45° FOV.
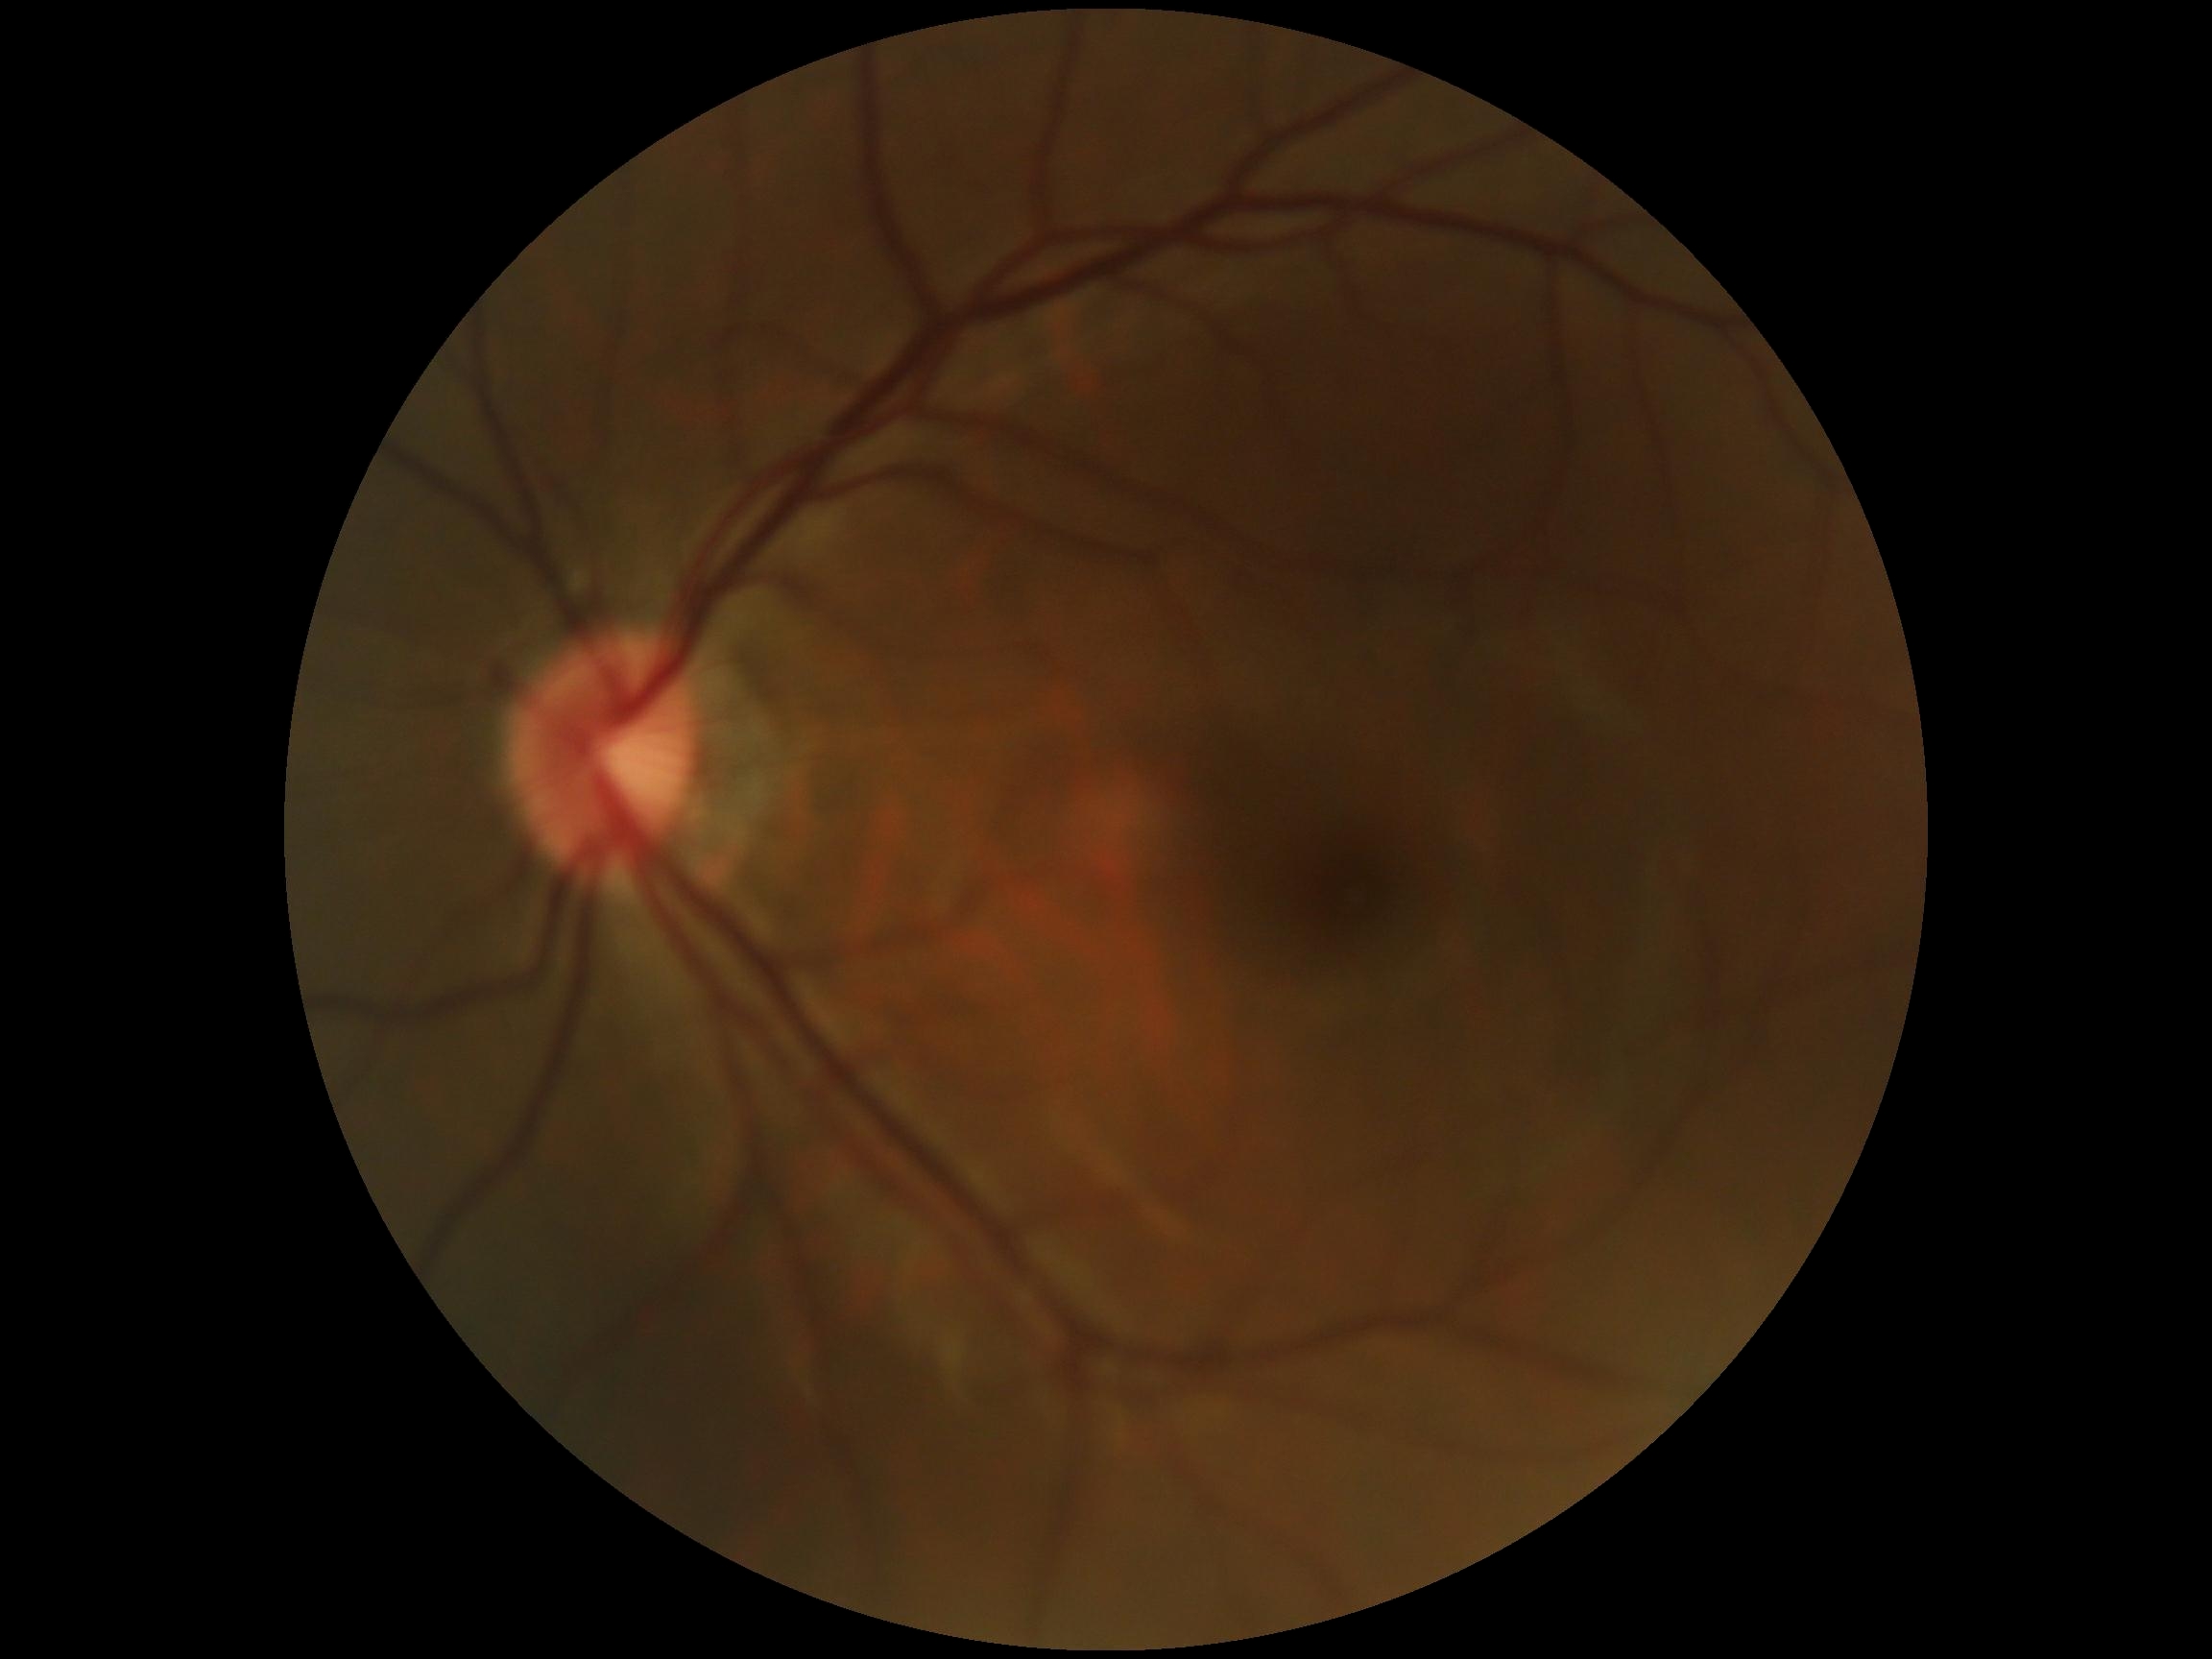

Annotations:
• retinopathy grade: no apparent retinopathy (0)